Disc-centered field:
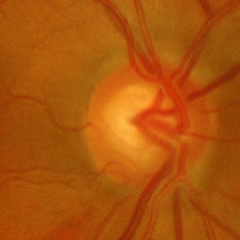

Glaucoma diagnosis: severe glaucomatous damage.